45° field of view; camera: NIDEK AFC-230 — 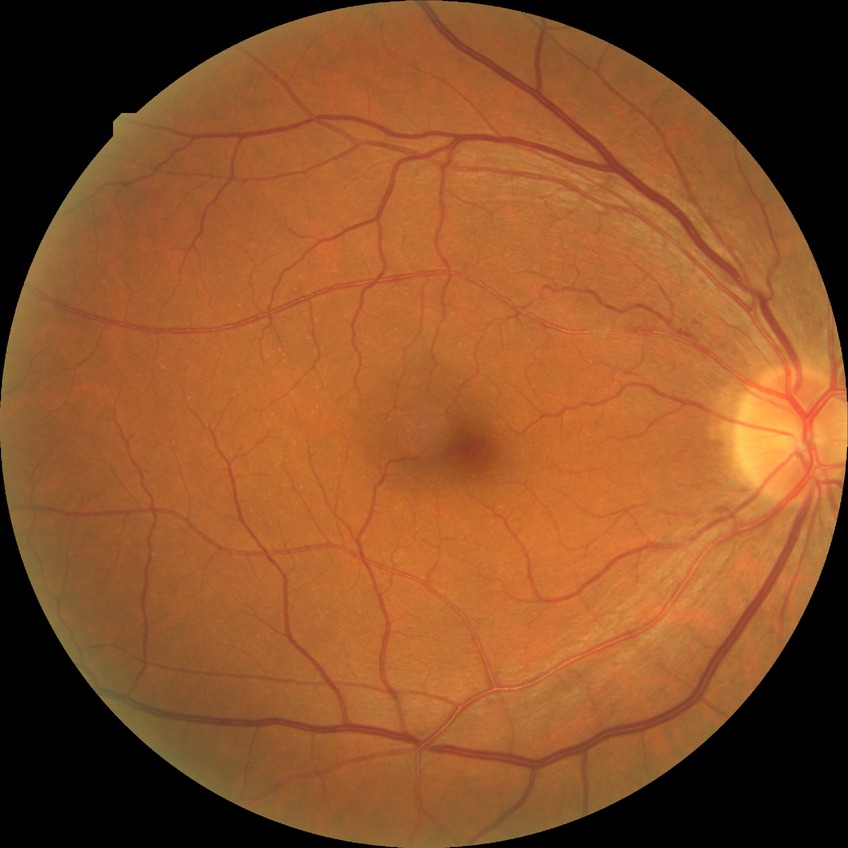

Davis grade: NDR. No DR findings.